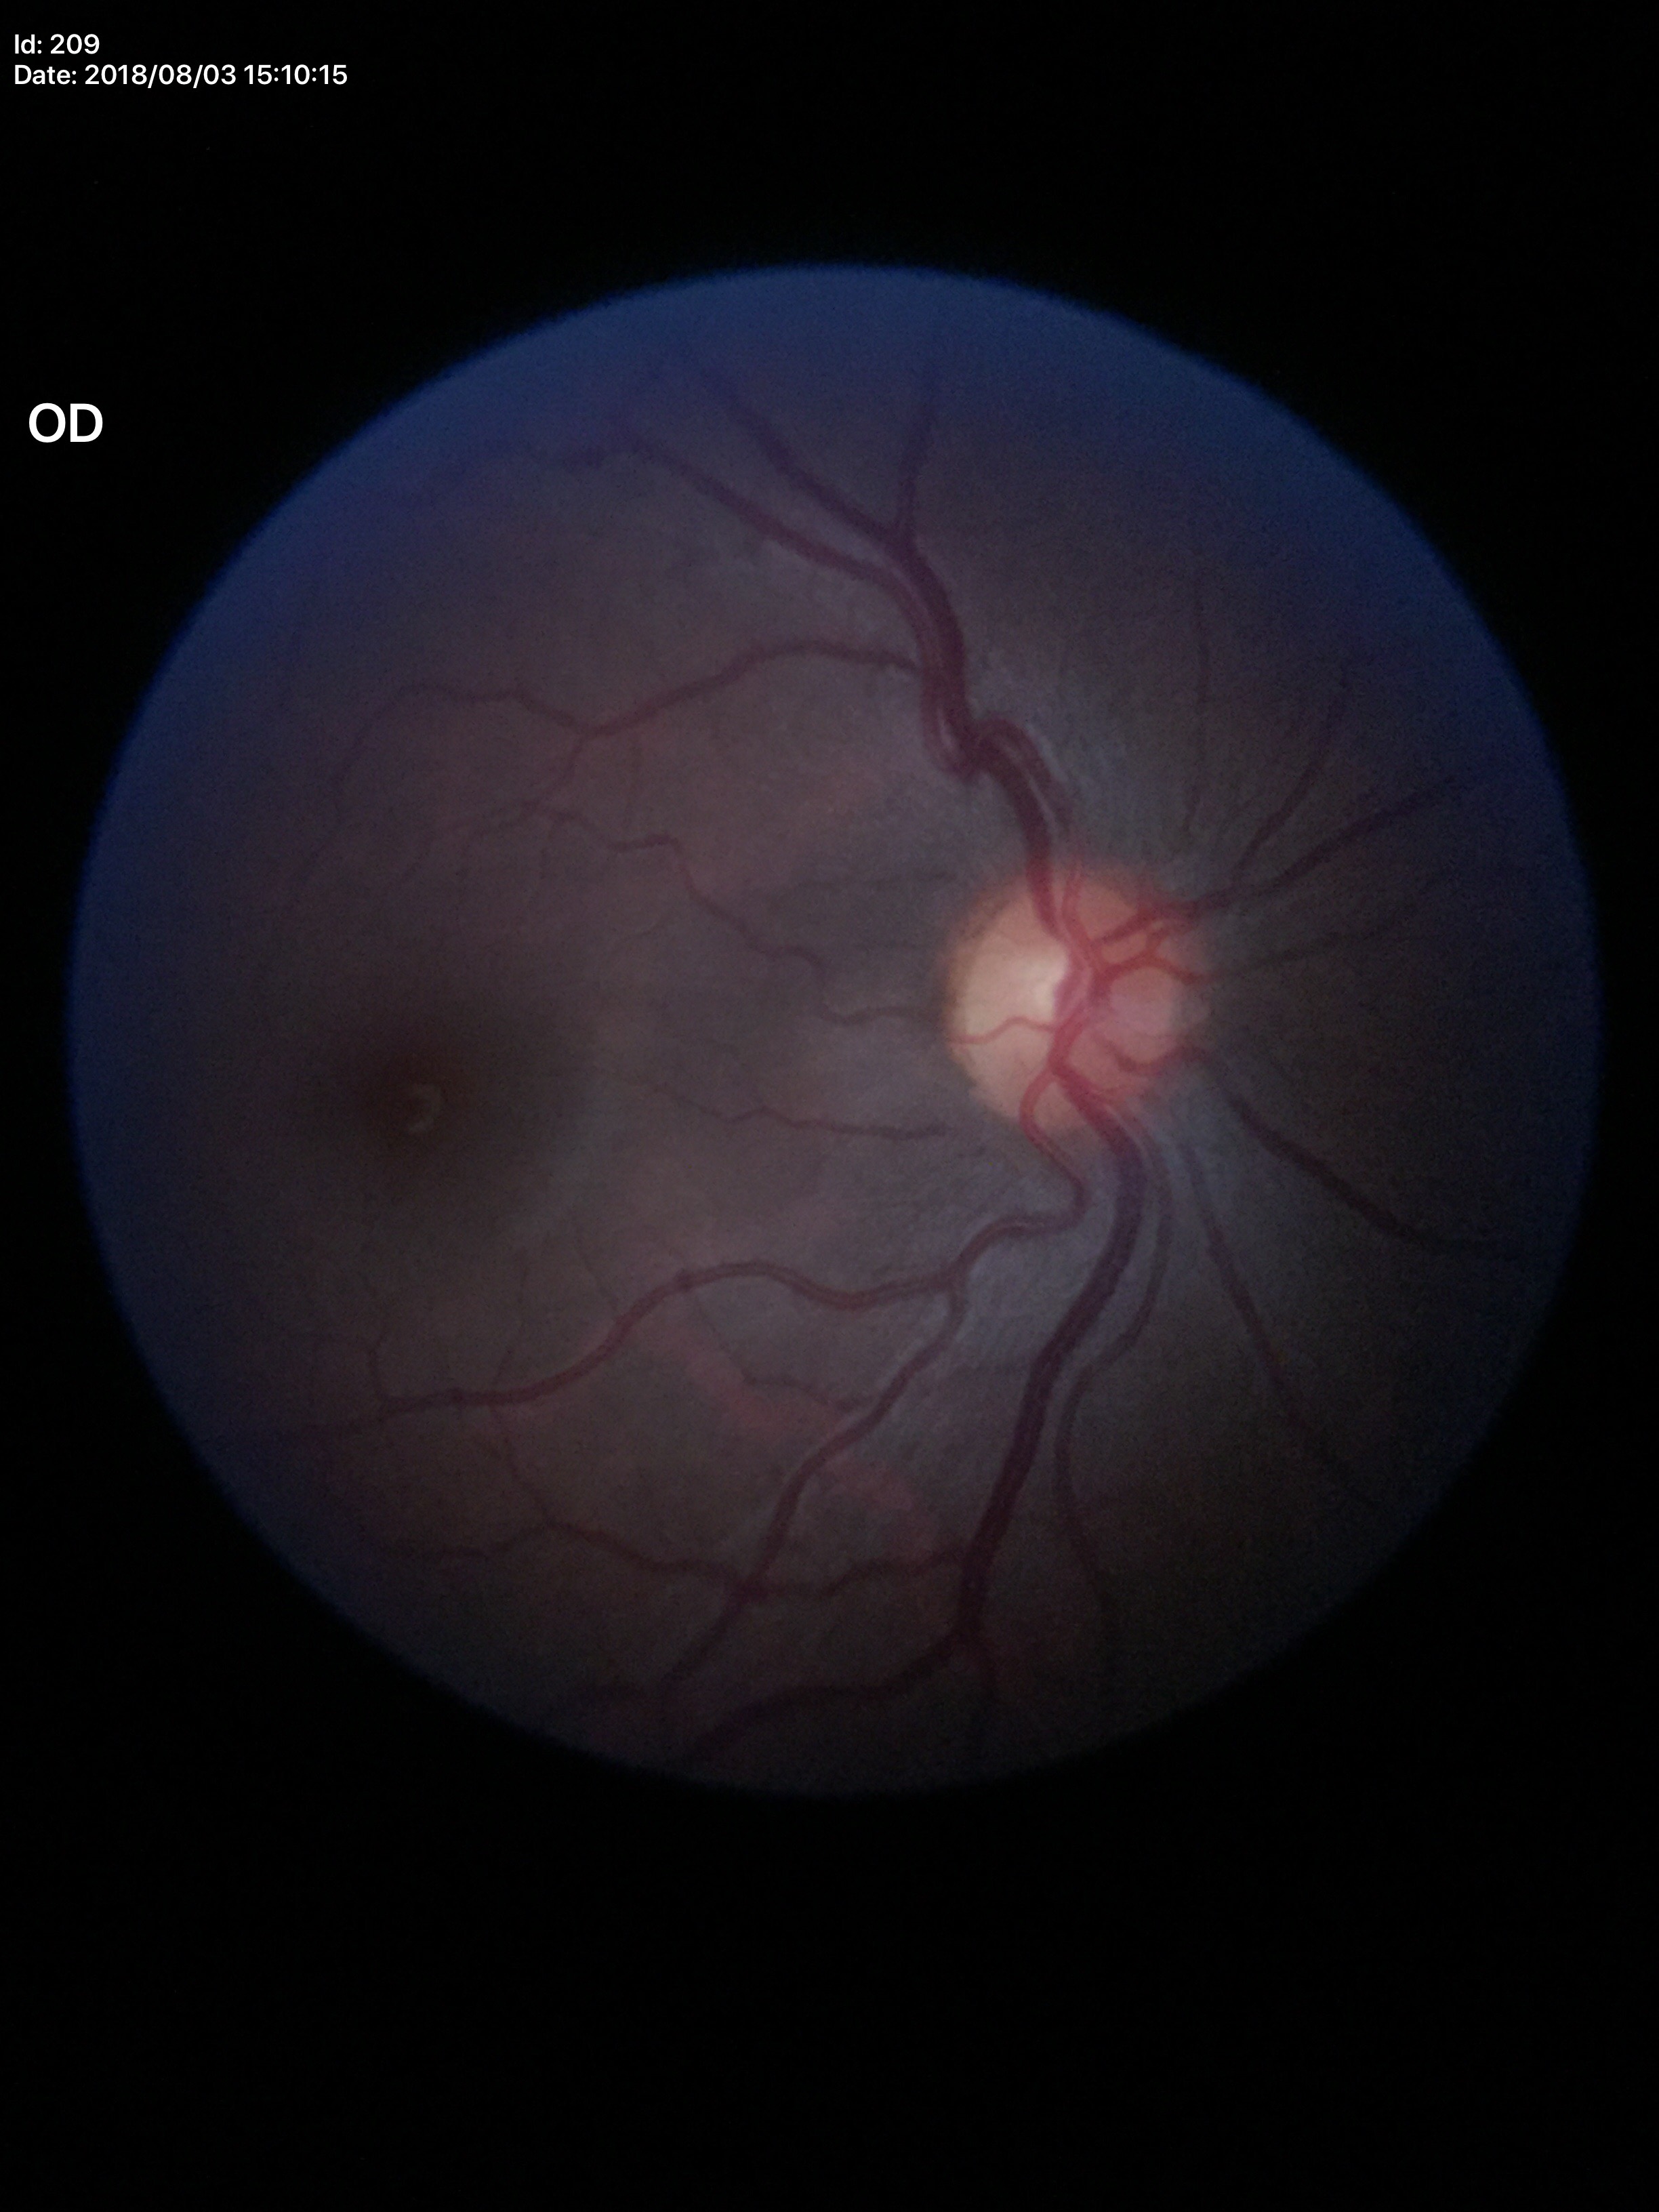

Glaucoma decision: not suspect, VCDR: 0.50.